Nonmydriatic · posterior pole photograph · 45-degree field of view · modified Davis classification · camera: NIDEK AFC-230 · 848x848 — 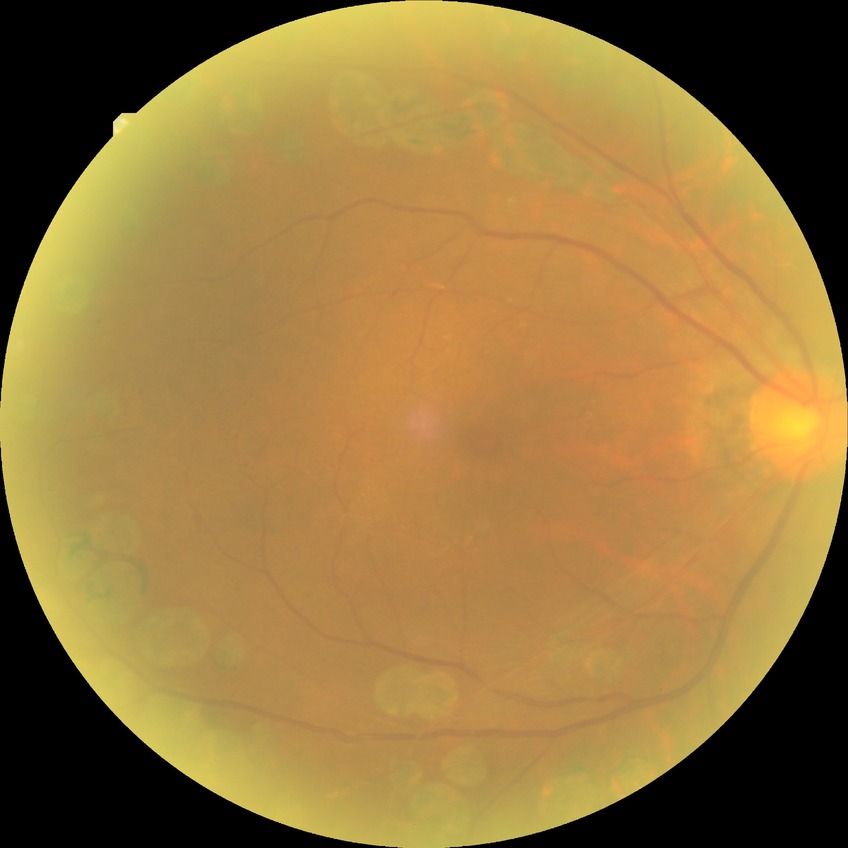
Davis grade: PDR.